Pediatric retinal photograph (wide-field): 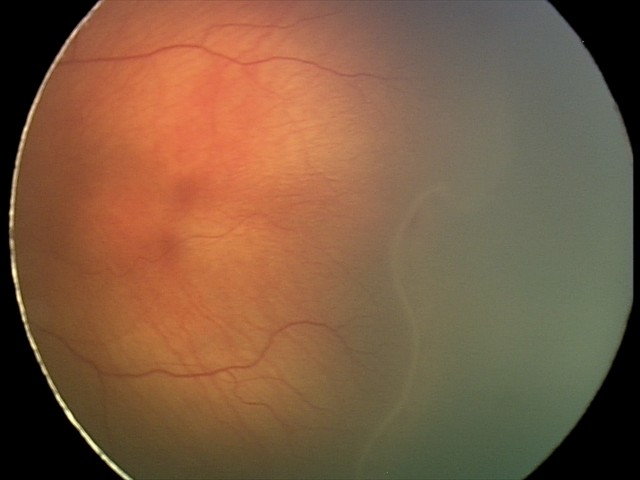
Screening series with retinopathy of prematurity stage 2. Plus disease absent.